Centered on the optic disc: 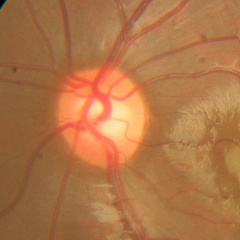 Assessment: no glaucomatous findings.